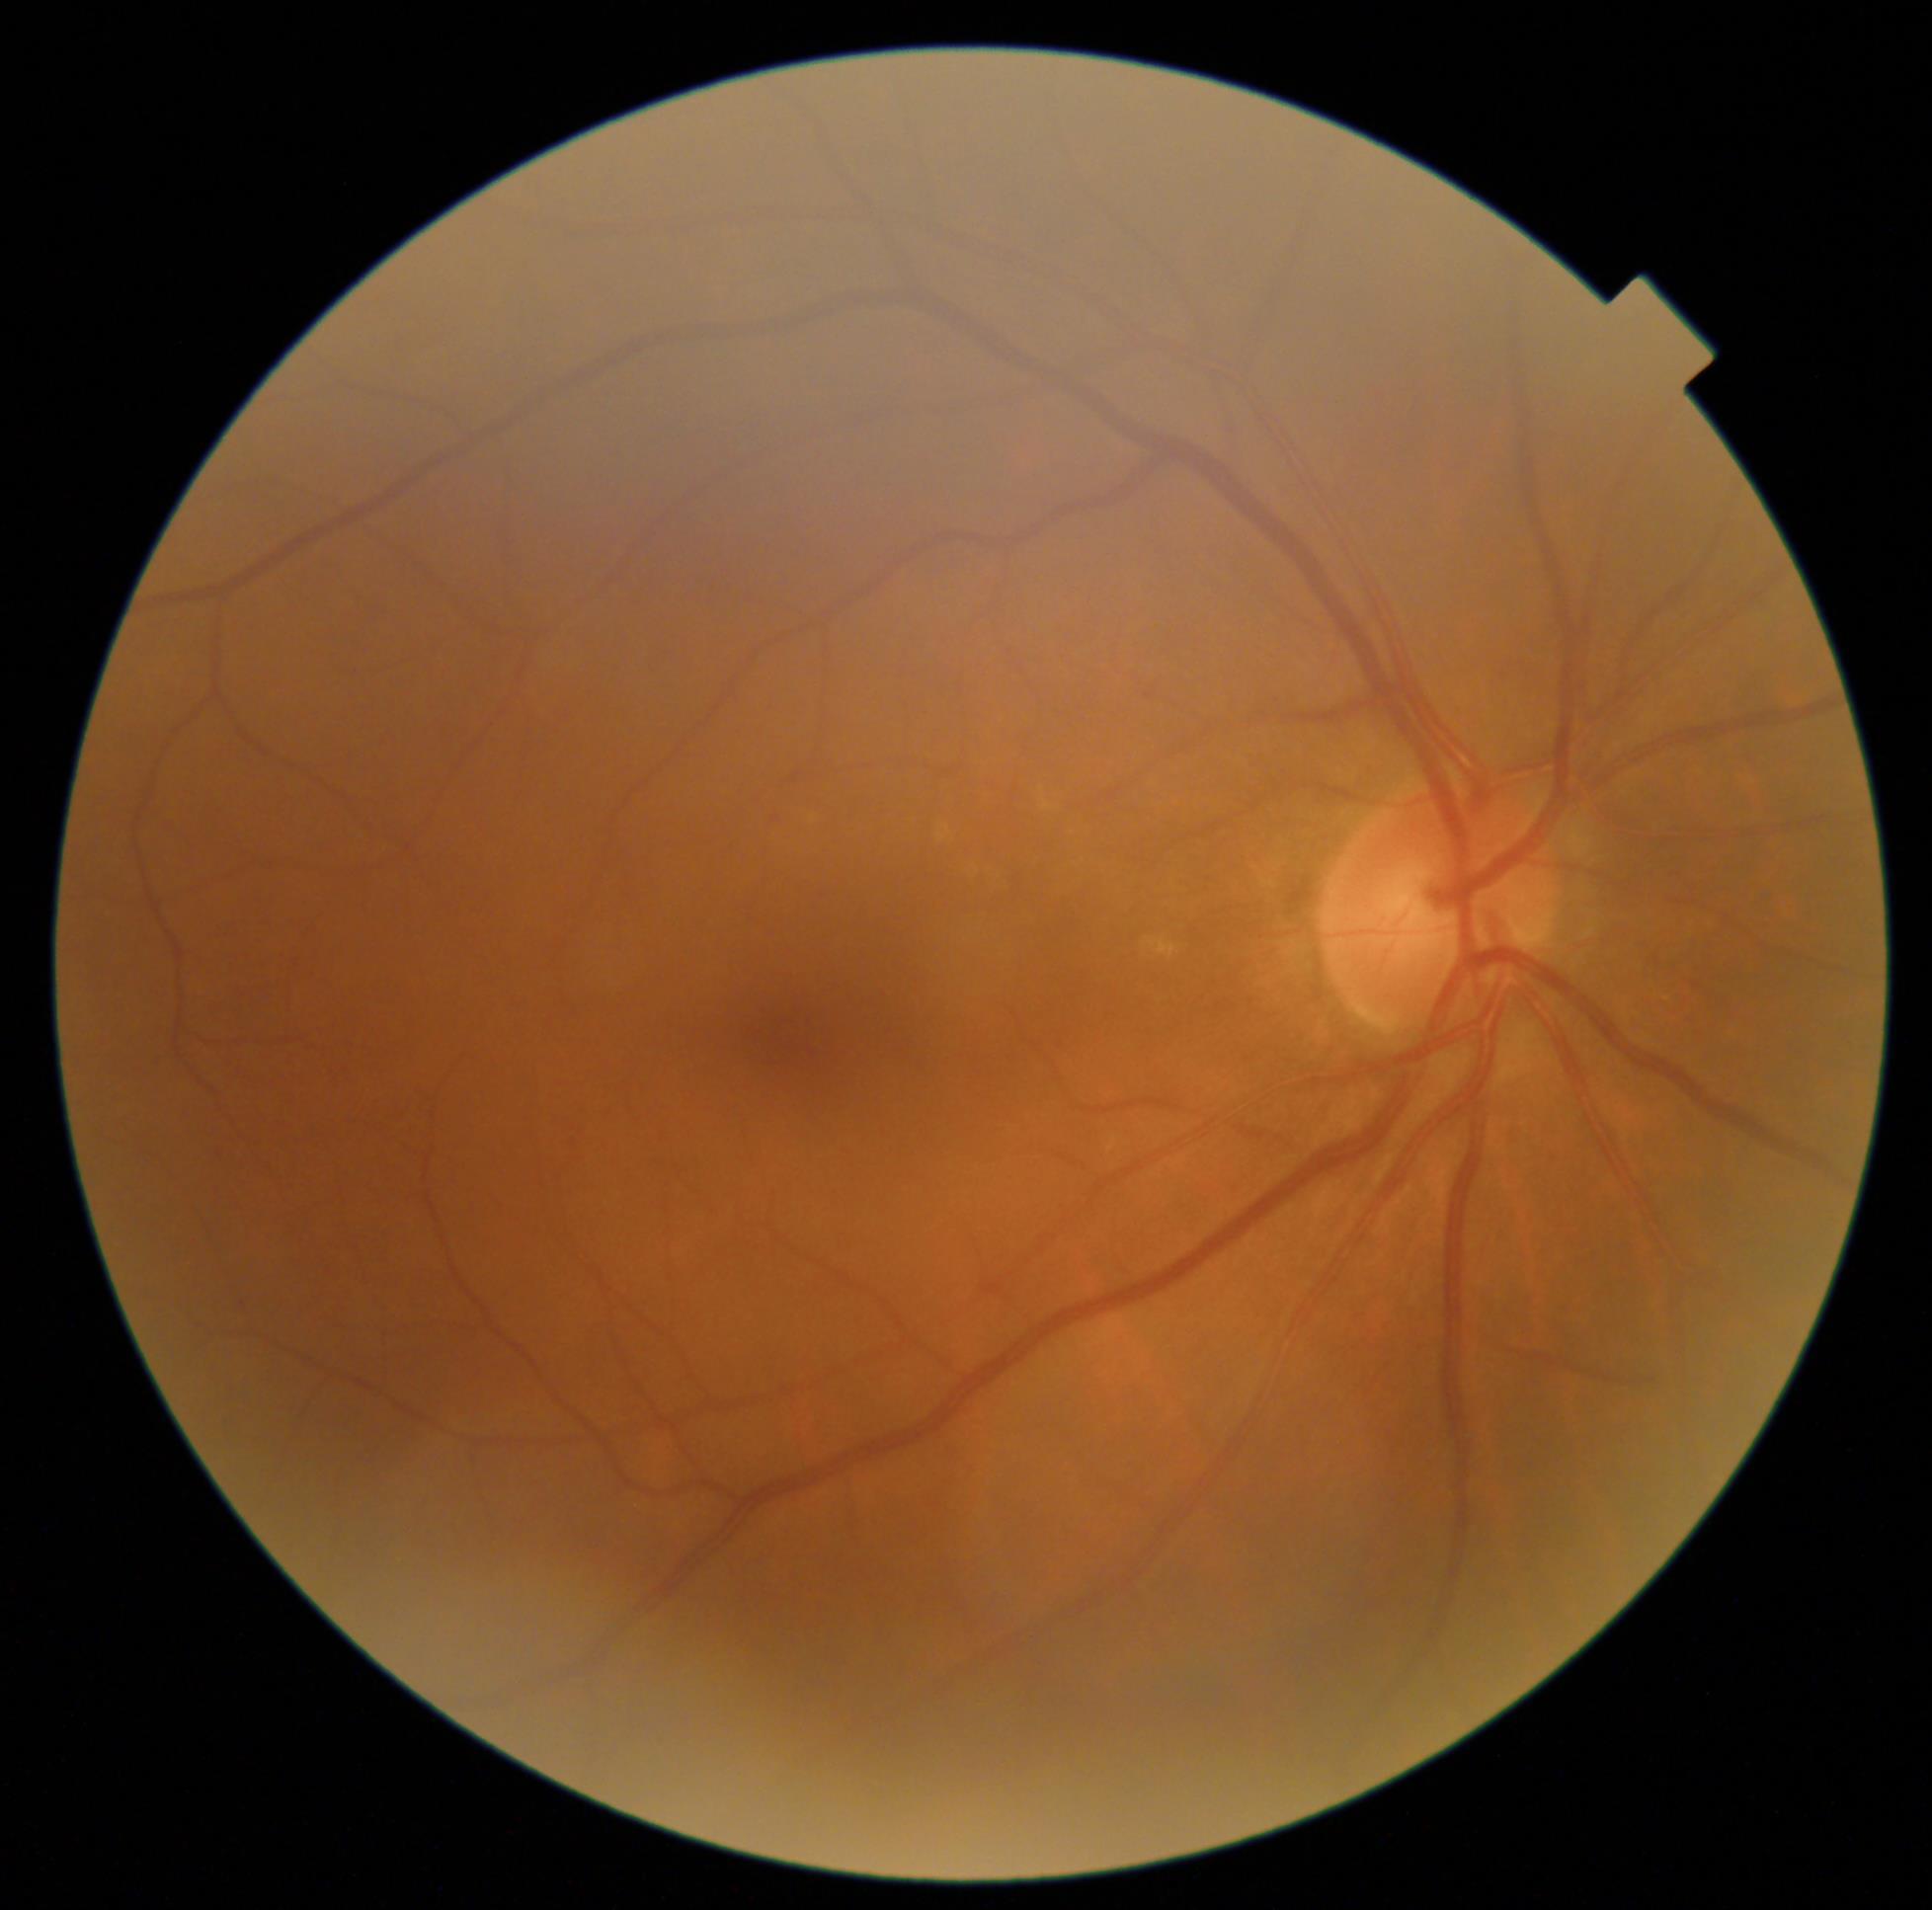 Diabetic retinopathy (DR) is no apparent diabetic retinopathy (grade 0) — no visible signs of diabetic retinopathy. No diabetic retinal disease findings.